Image size 1932x1910, 45° FOV, color fundus image: 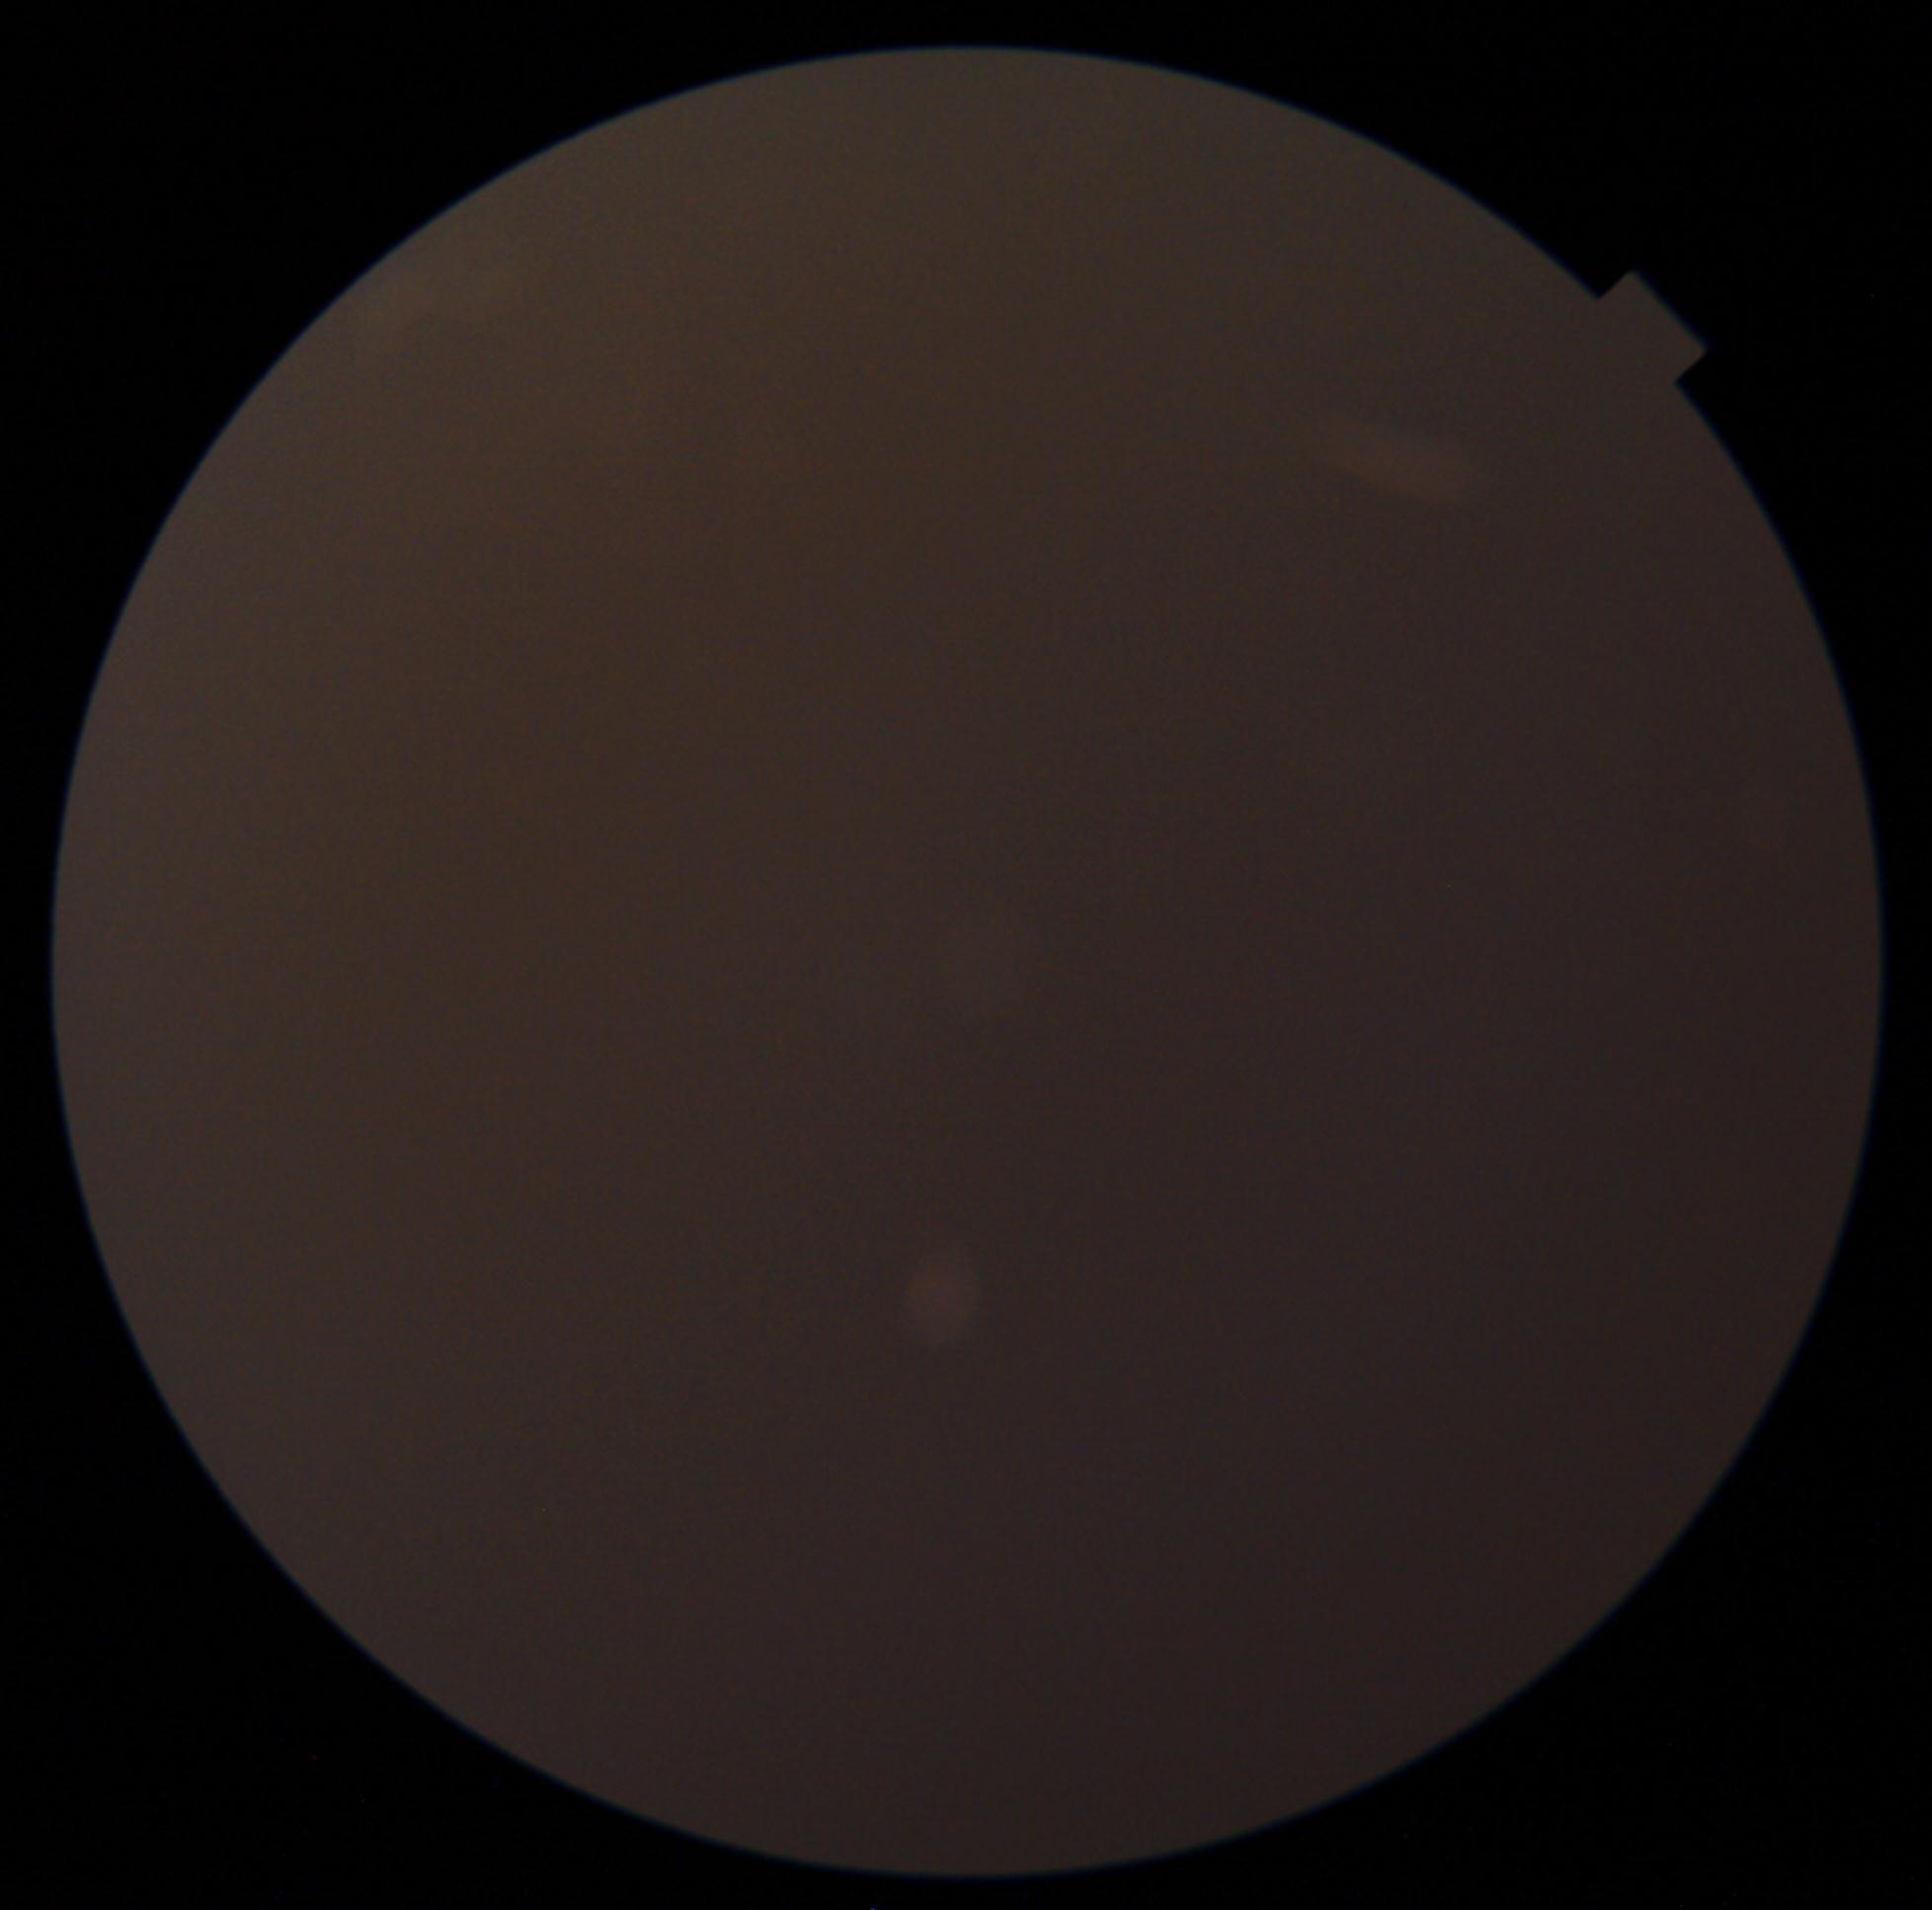 image quality=too poor for DR grading; DR grade=ungradable due to poor image quality.